Pediatric retinal photograph (wide-field): 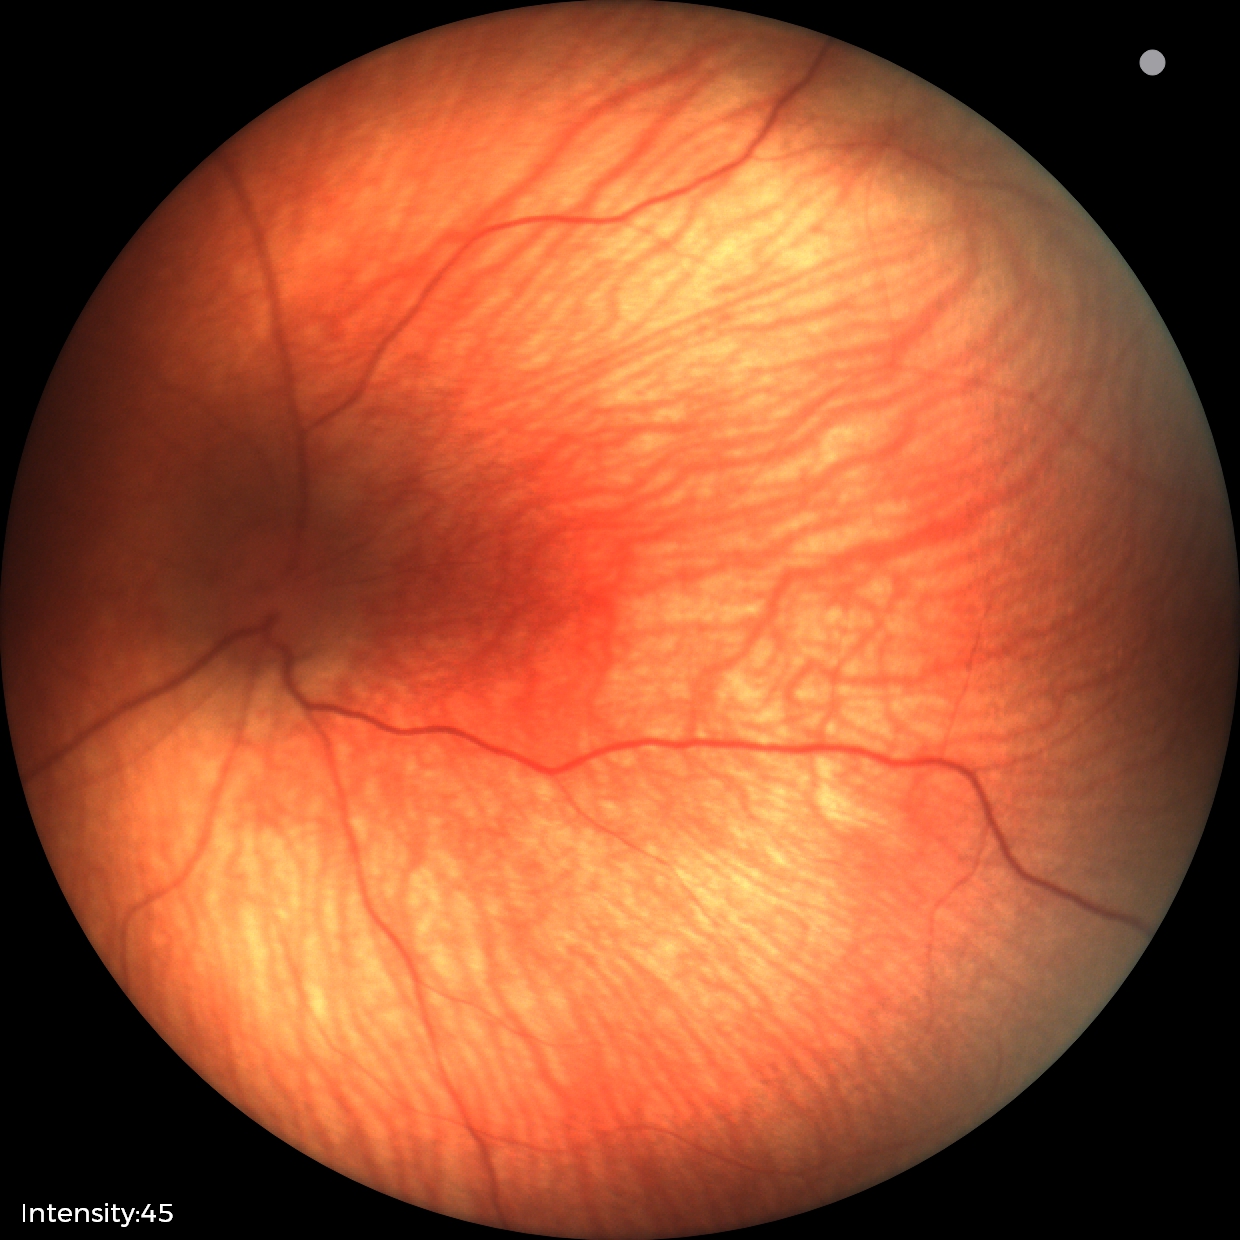
Screening examination diagnosed as physiological.